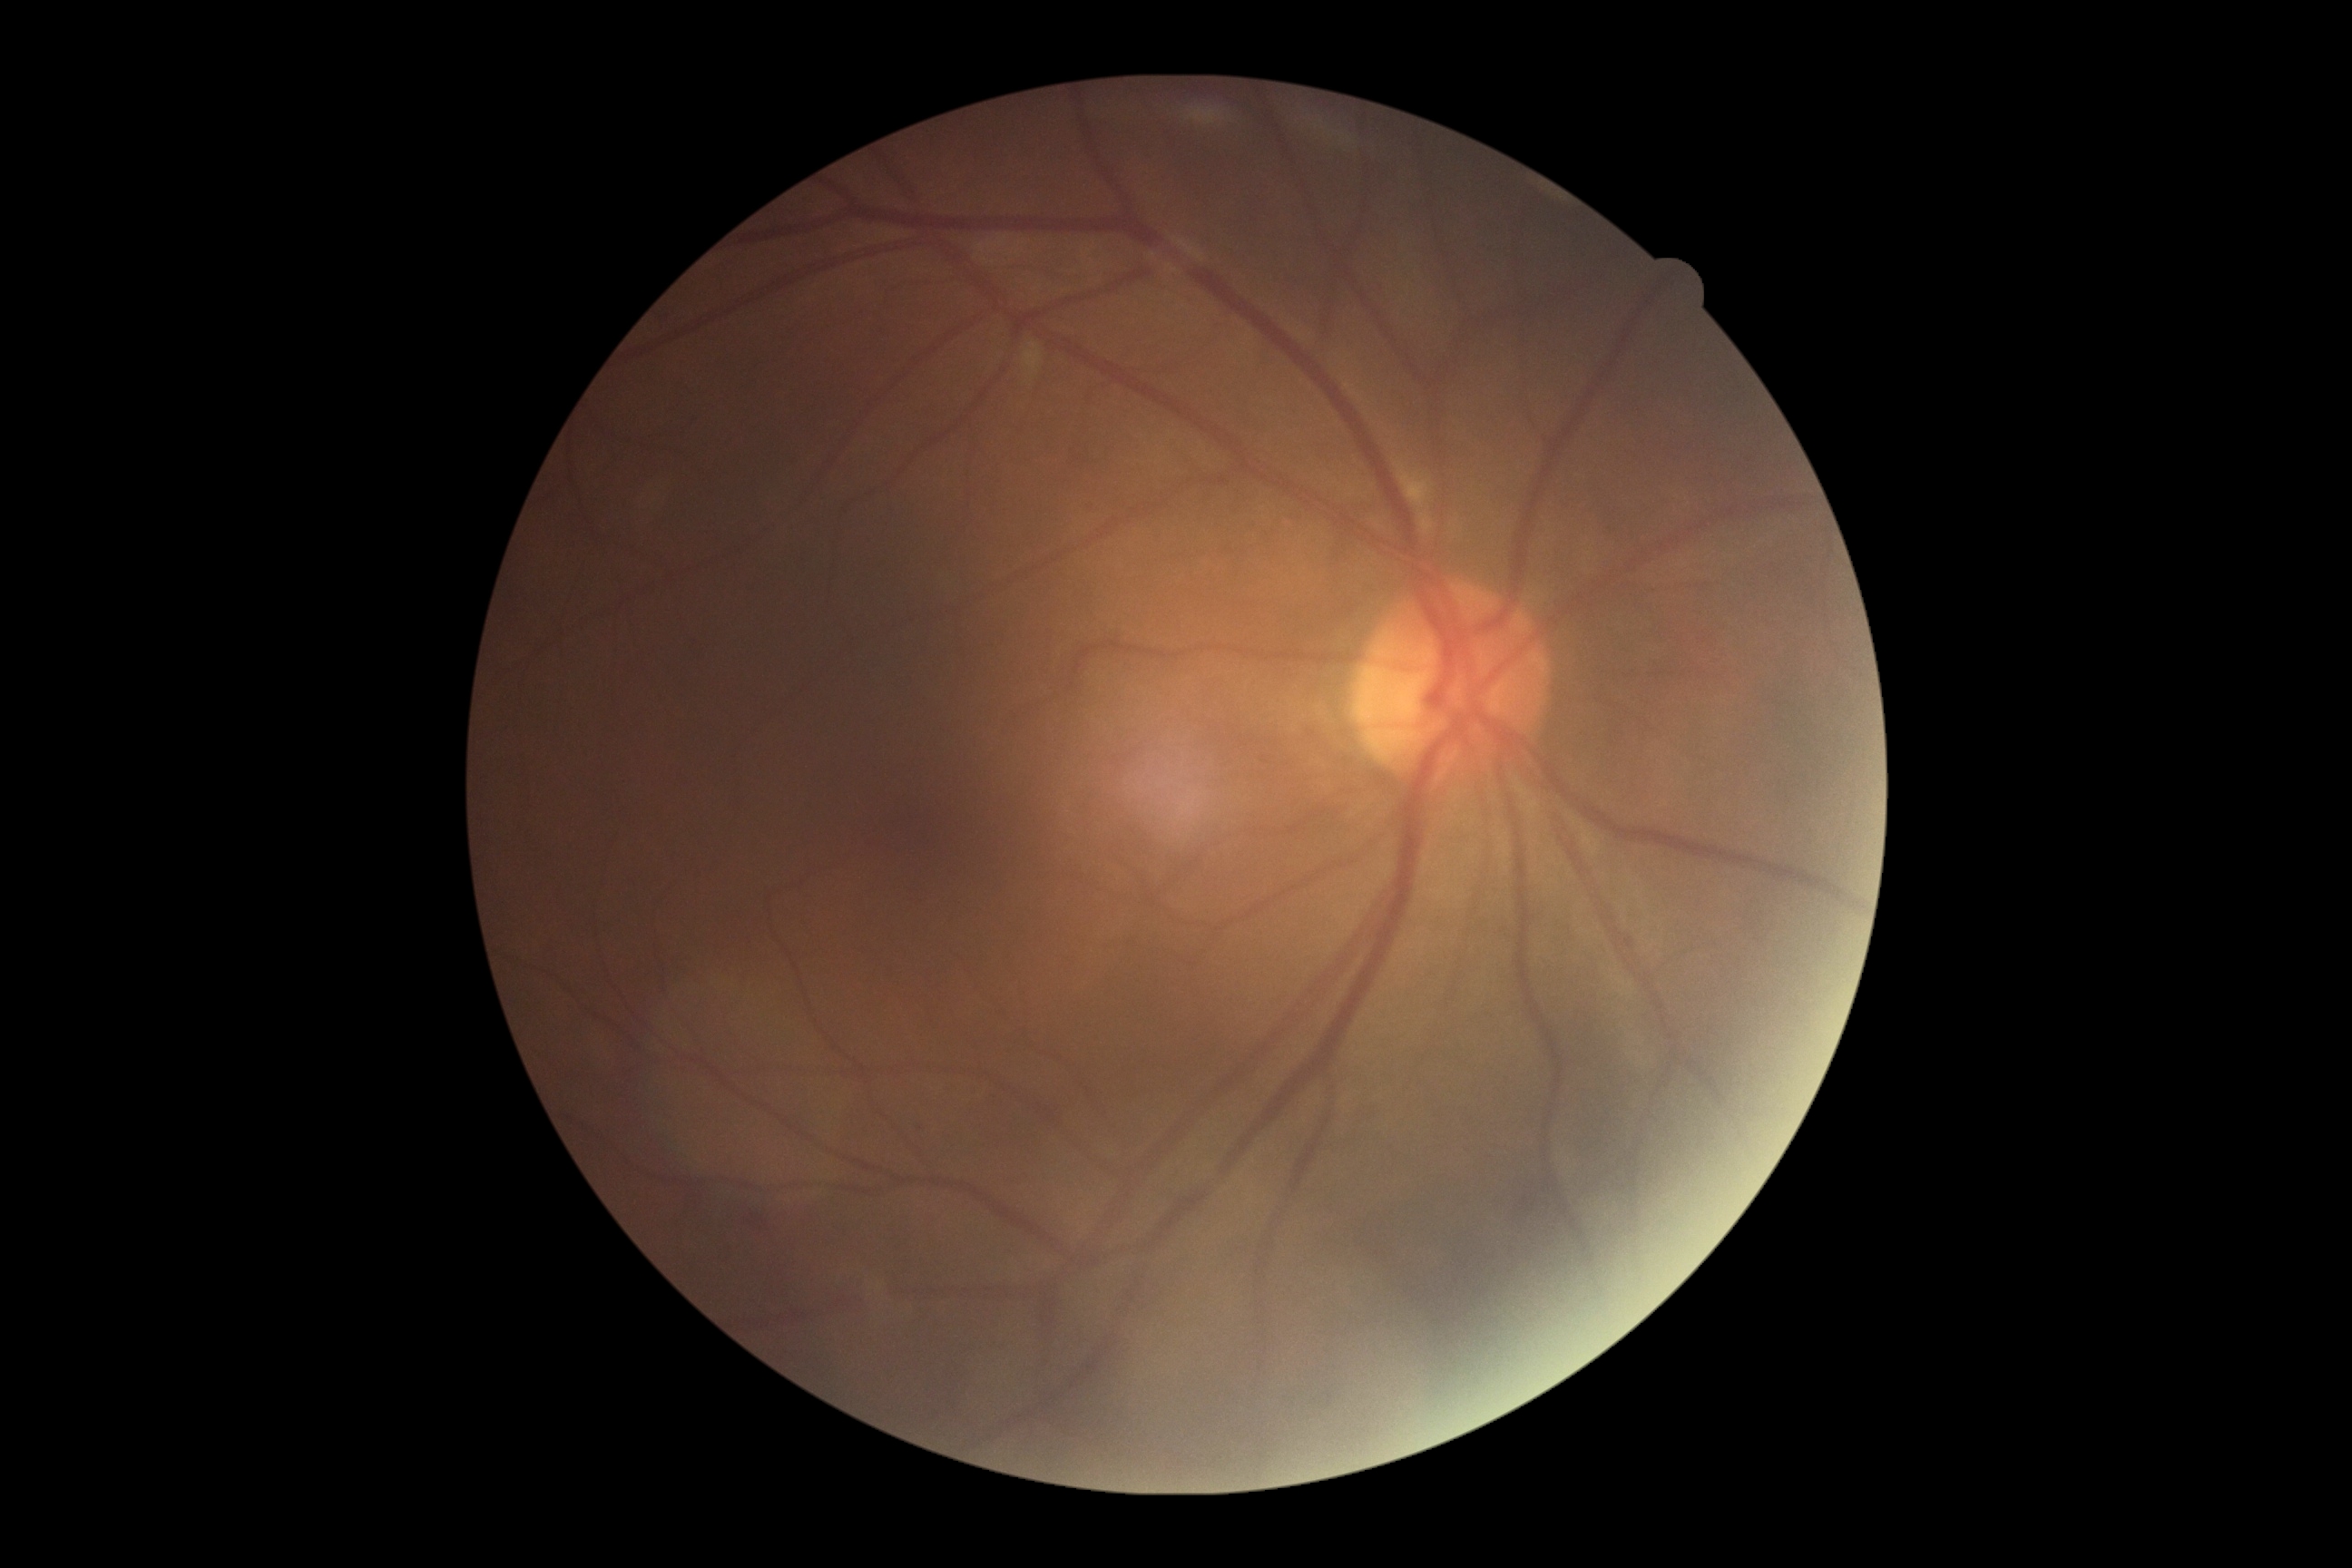 Diabetic retinopathy grade is 2/4.